Davis DR grading
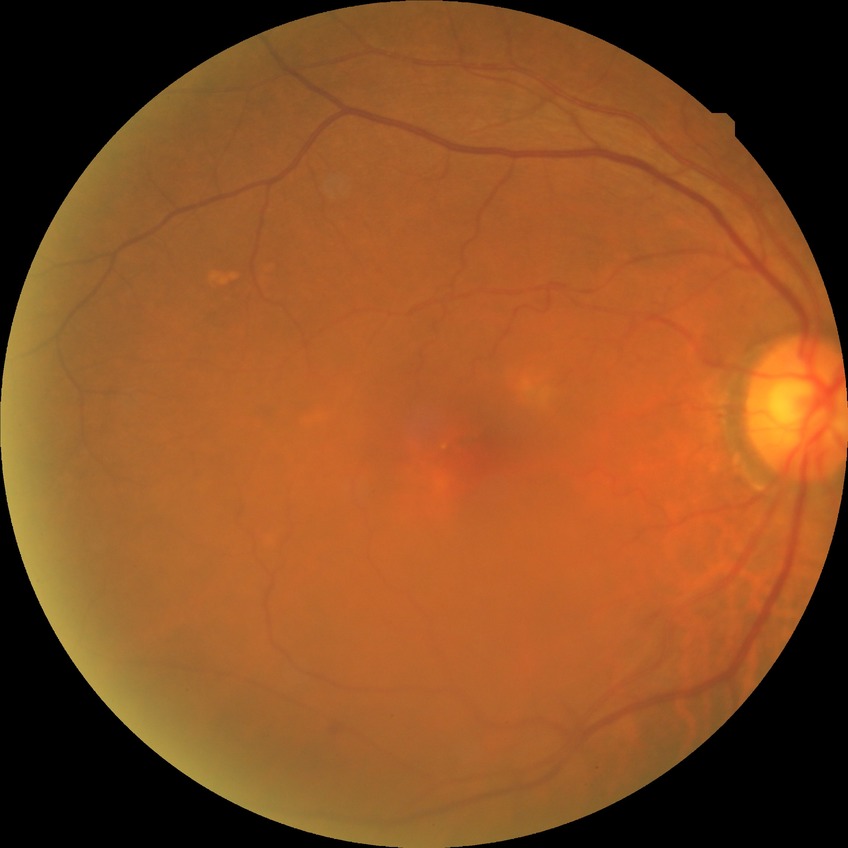

Davis grade=NDR.